Non-mydriatic acquisition · 240x240px
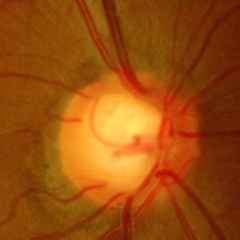 Findings consistent with glaucoma. Demonstrates advanced-stage glaucoma.